2352x1568 · 45° FOV.
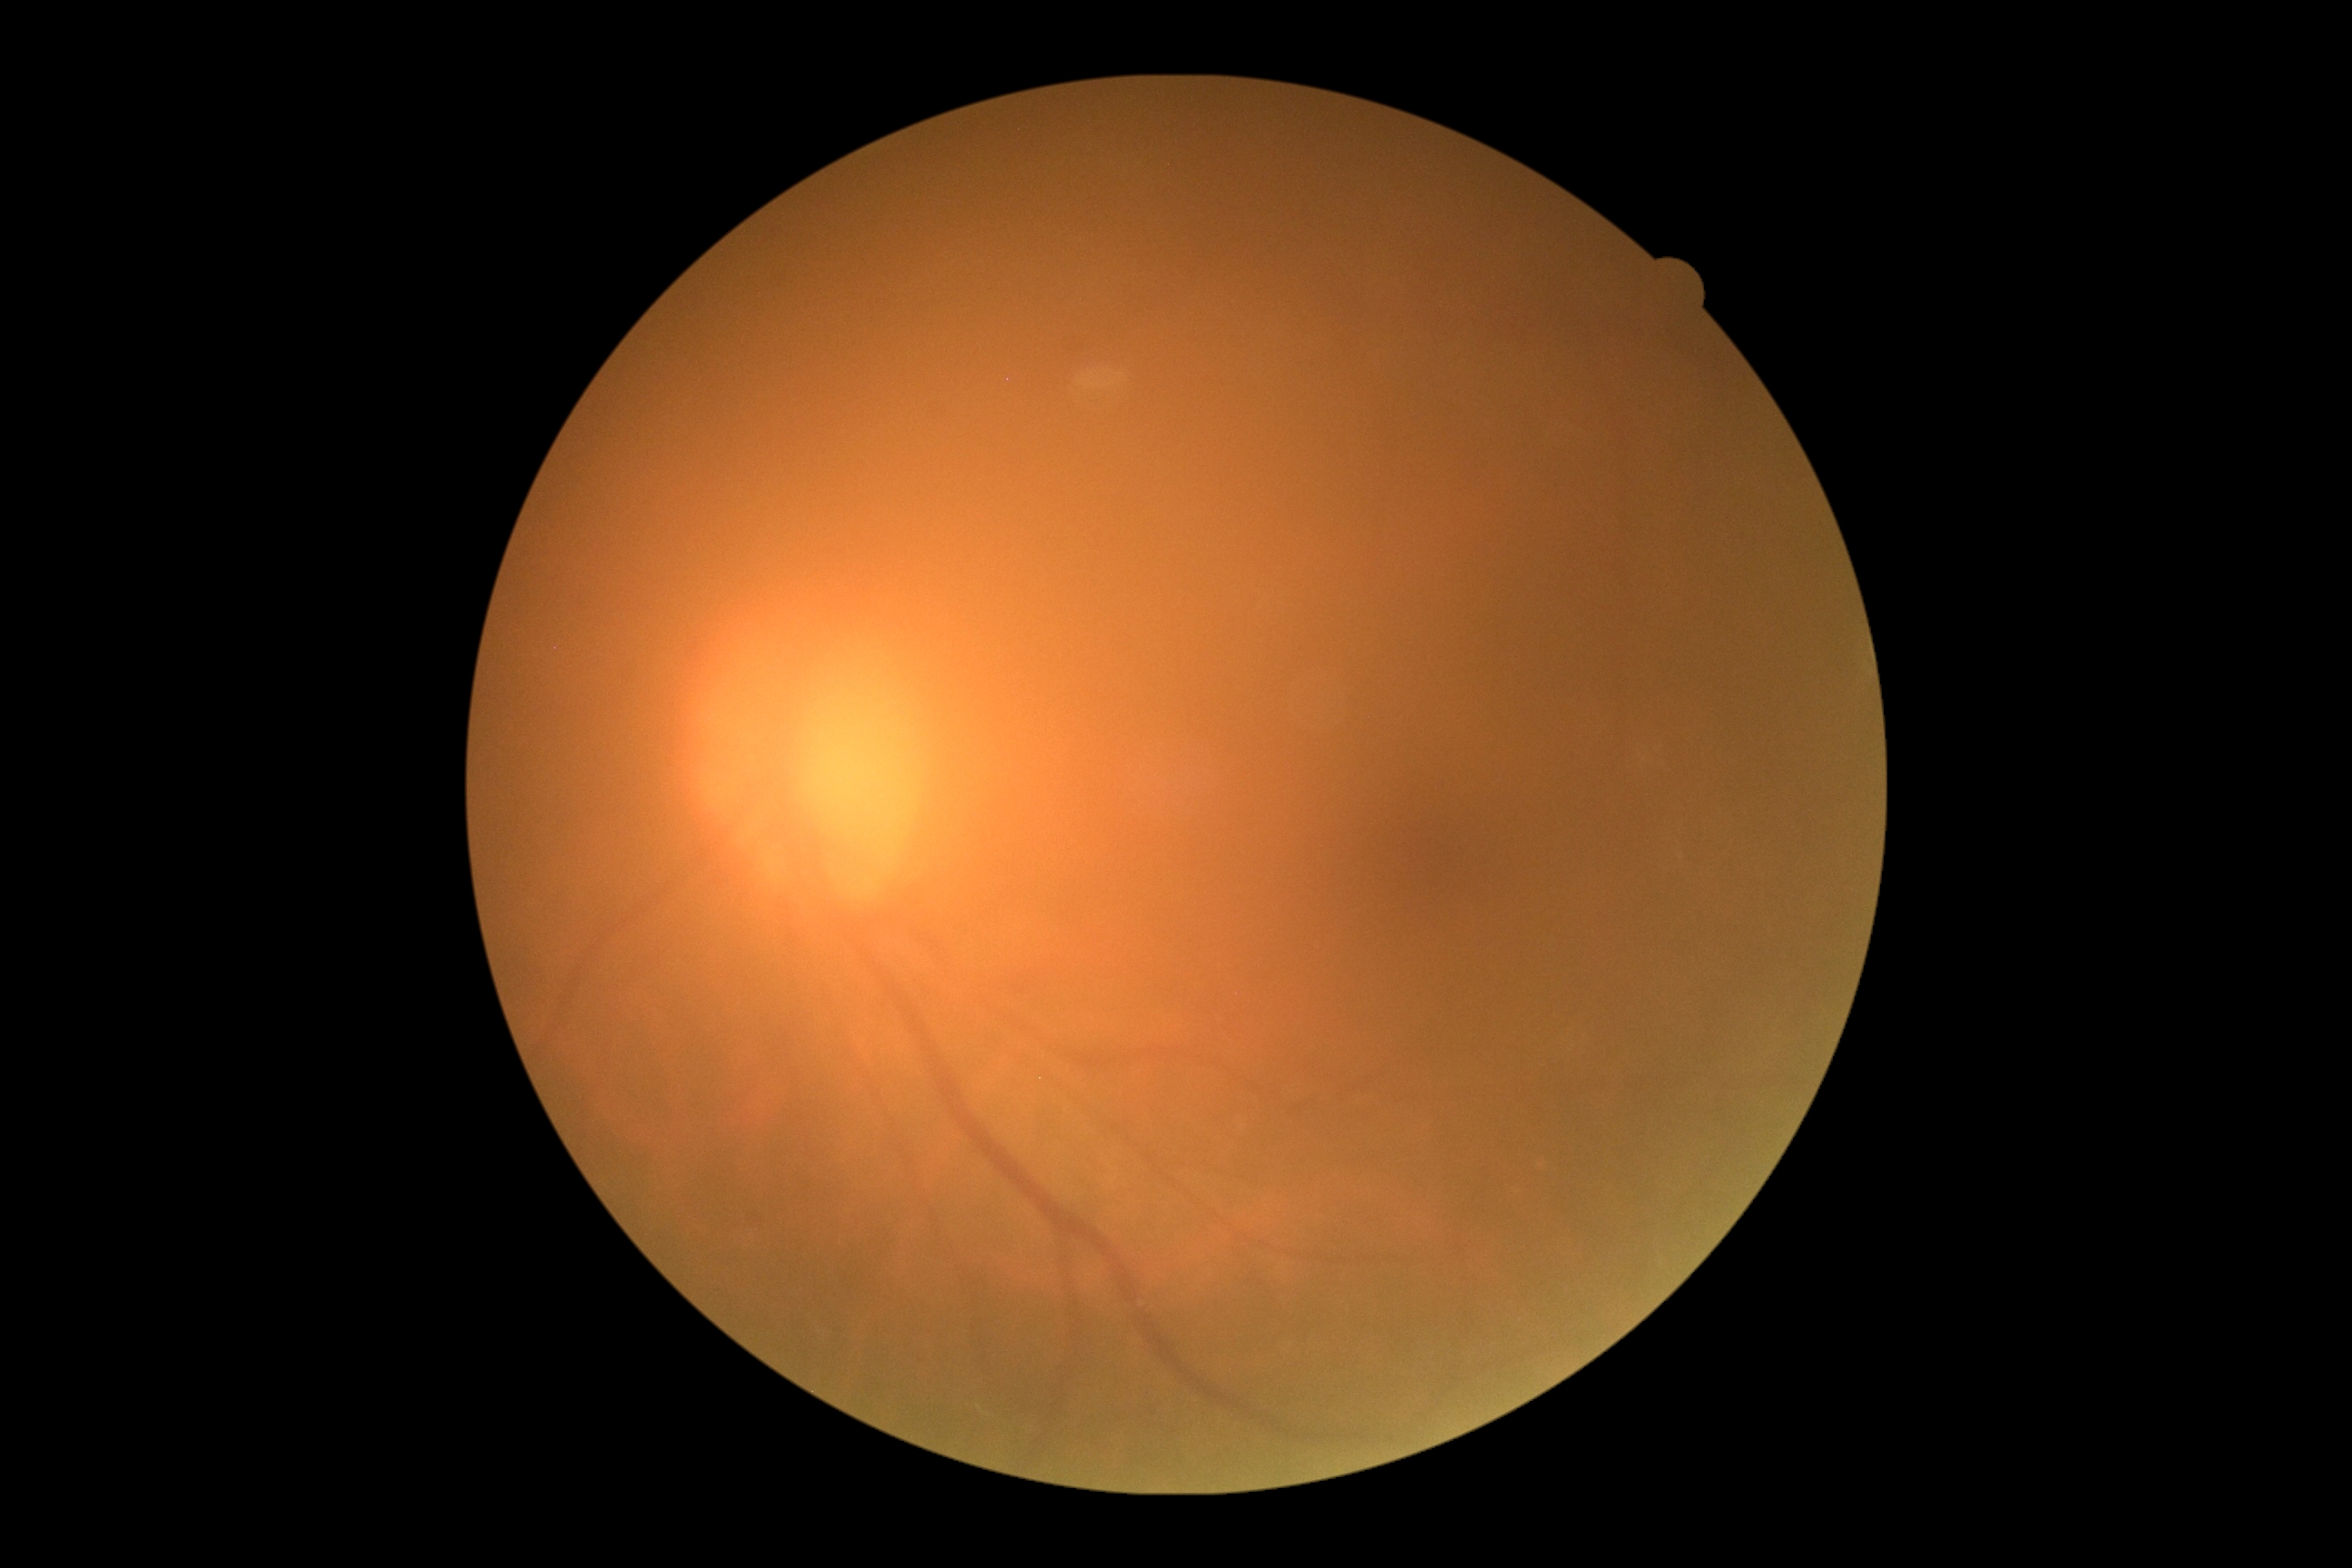

Retinopathy: no apparent diabetic retinopathy (grade 0).